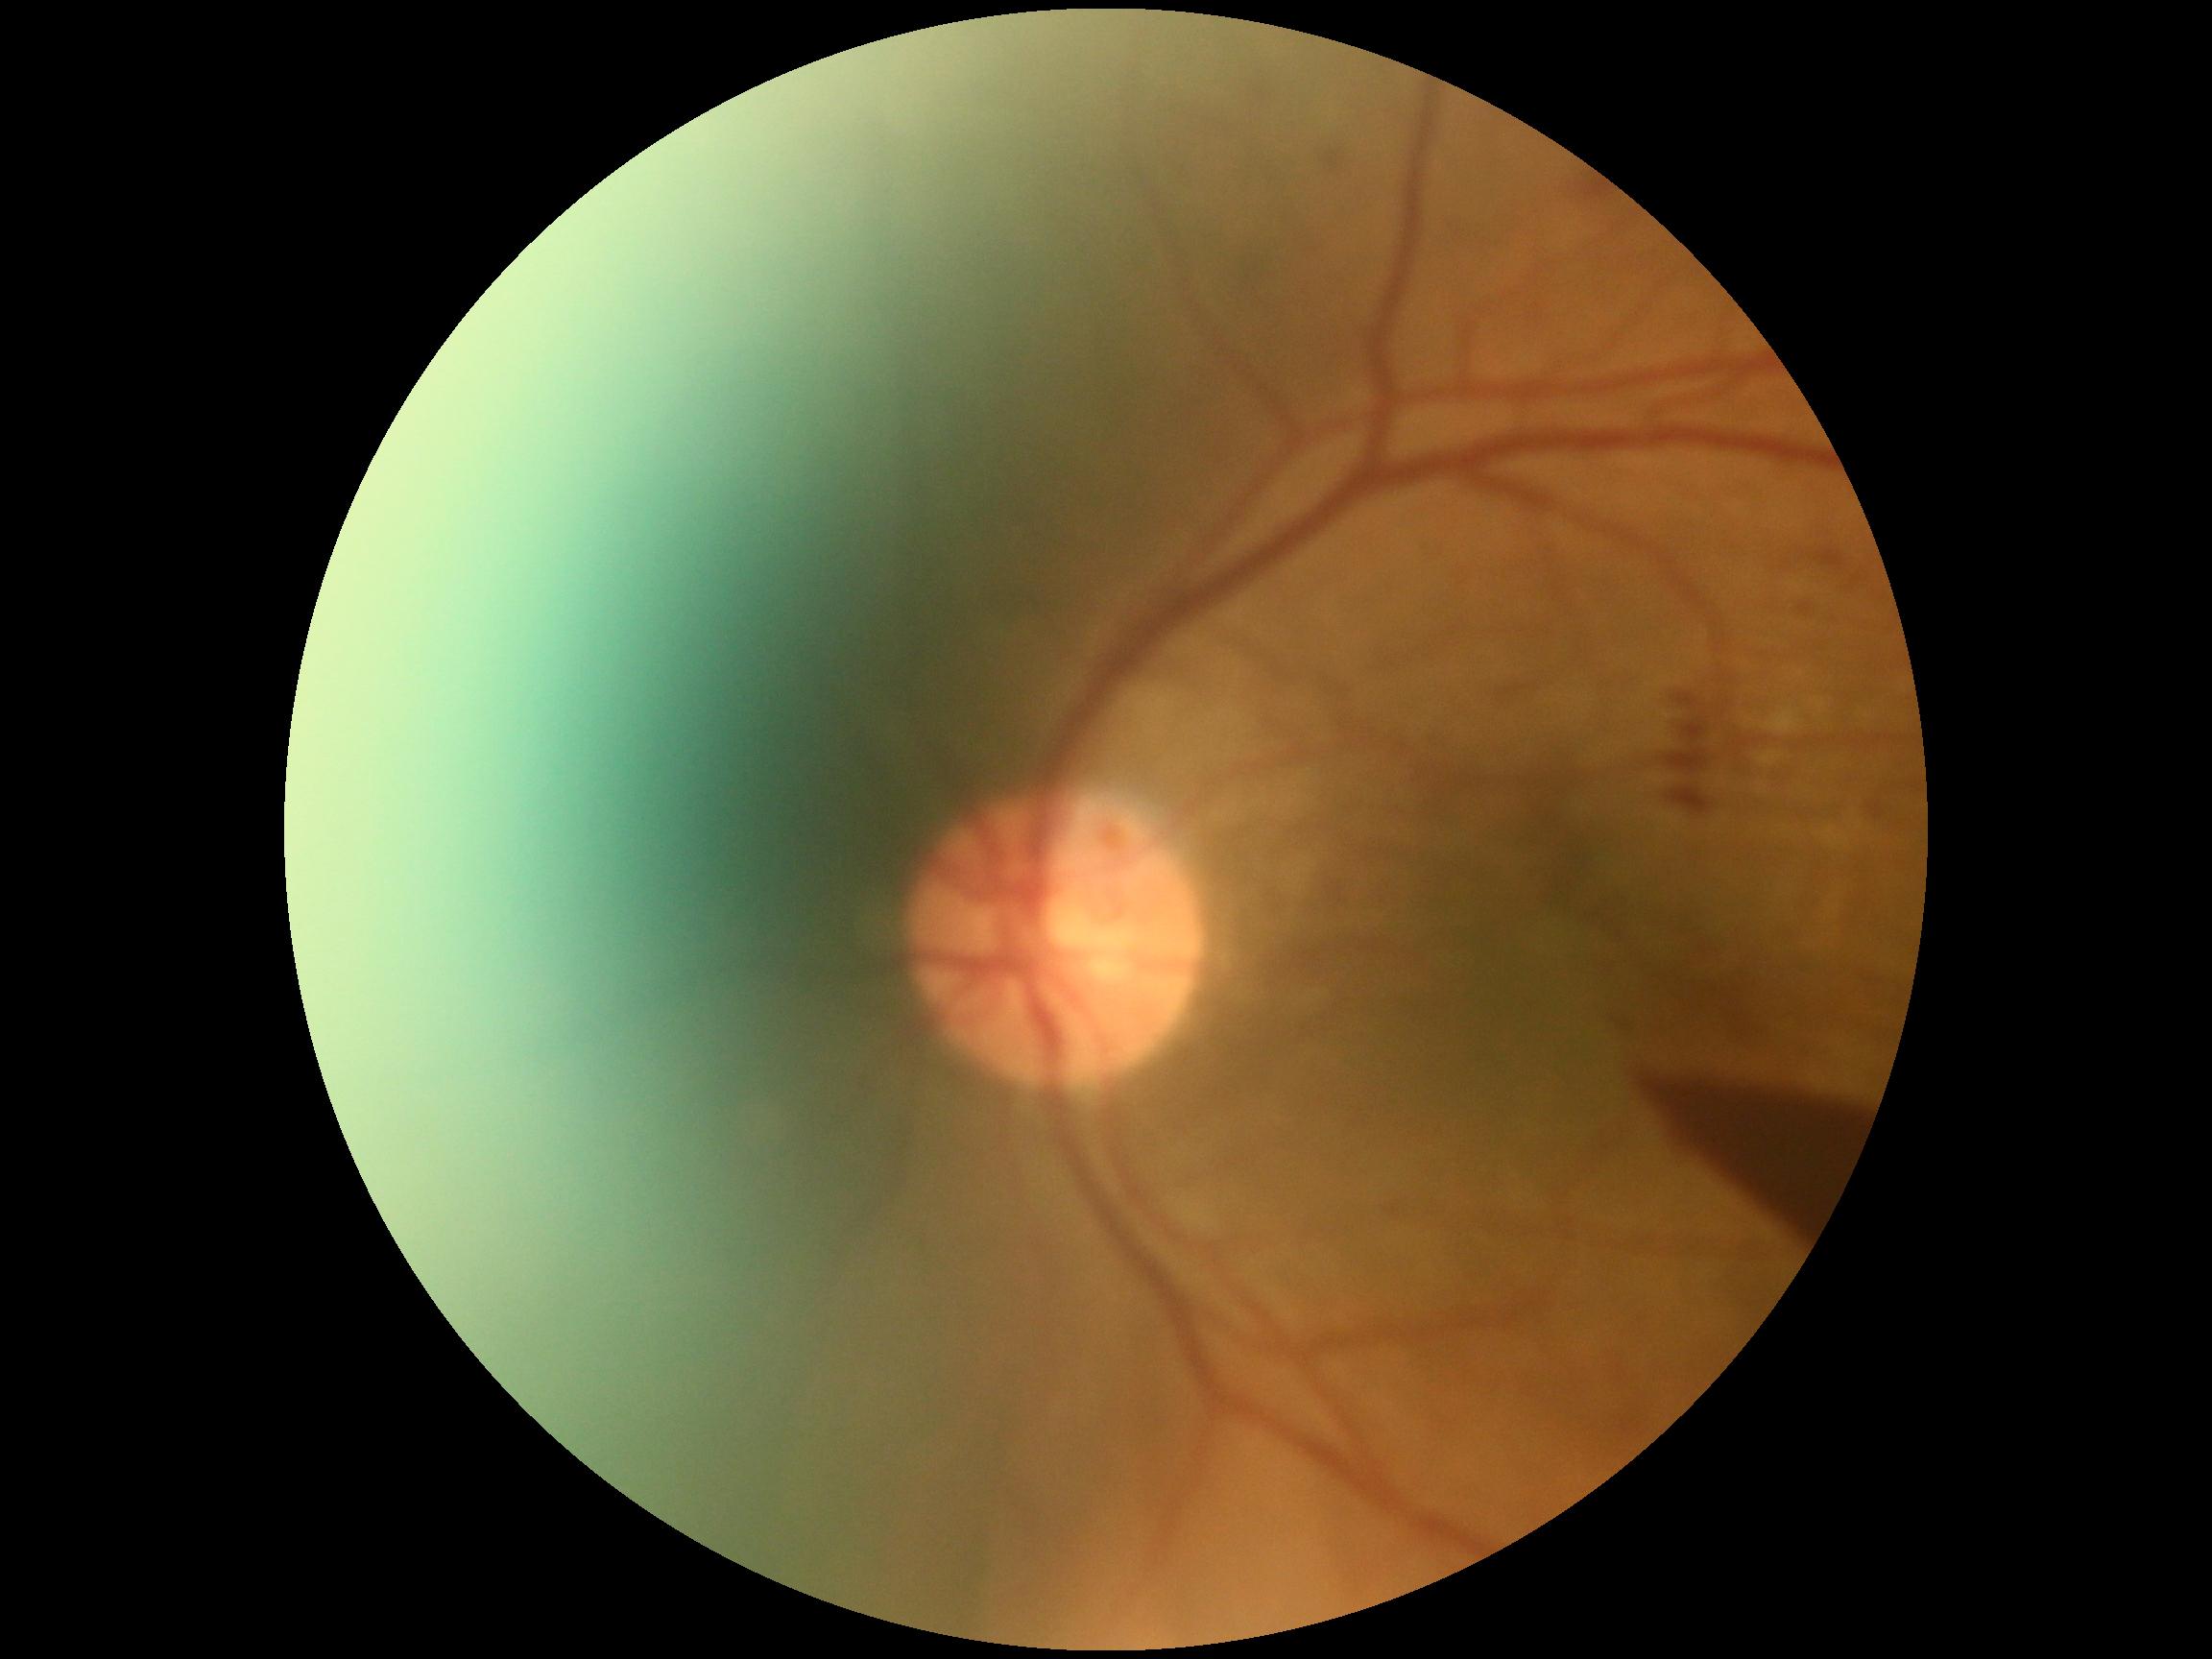
diabetic retinopathy: PDR (grade 4).